Modified Davis classification. FOV: 45 degrees. Nonmydriatic. 848 x 848 pixels — 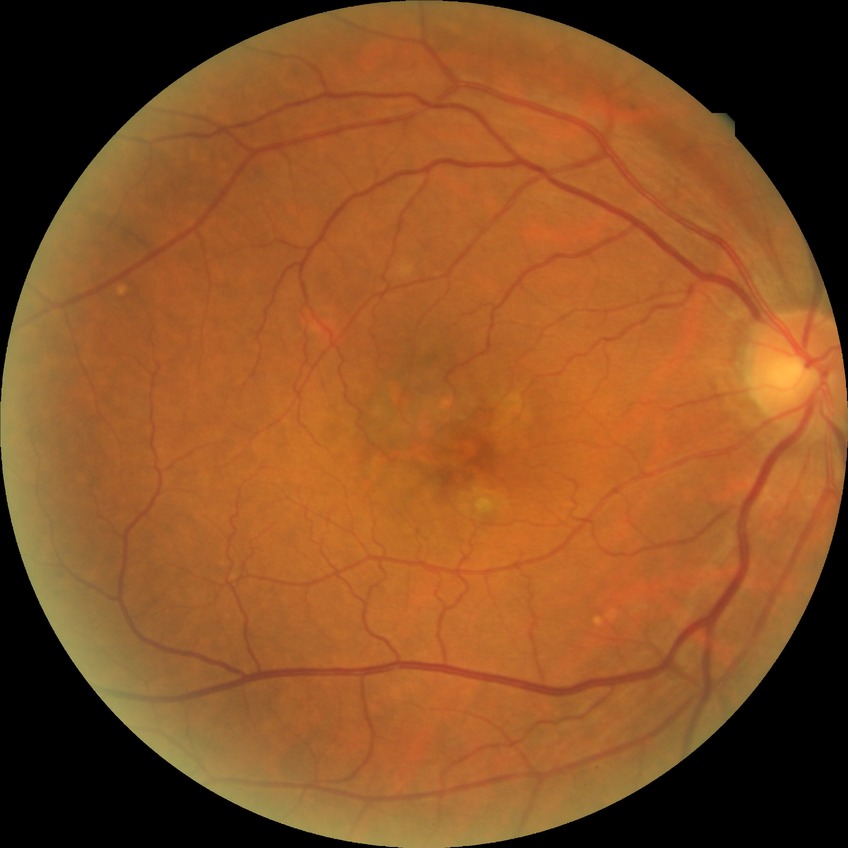
Annotations:
• Davis DR grade — NDR